Modified Davis grading. 45° FOV. 848x848px.
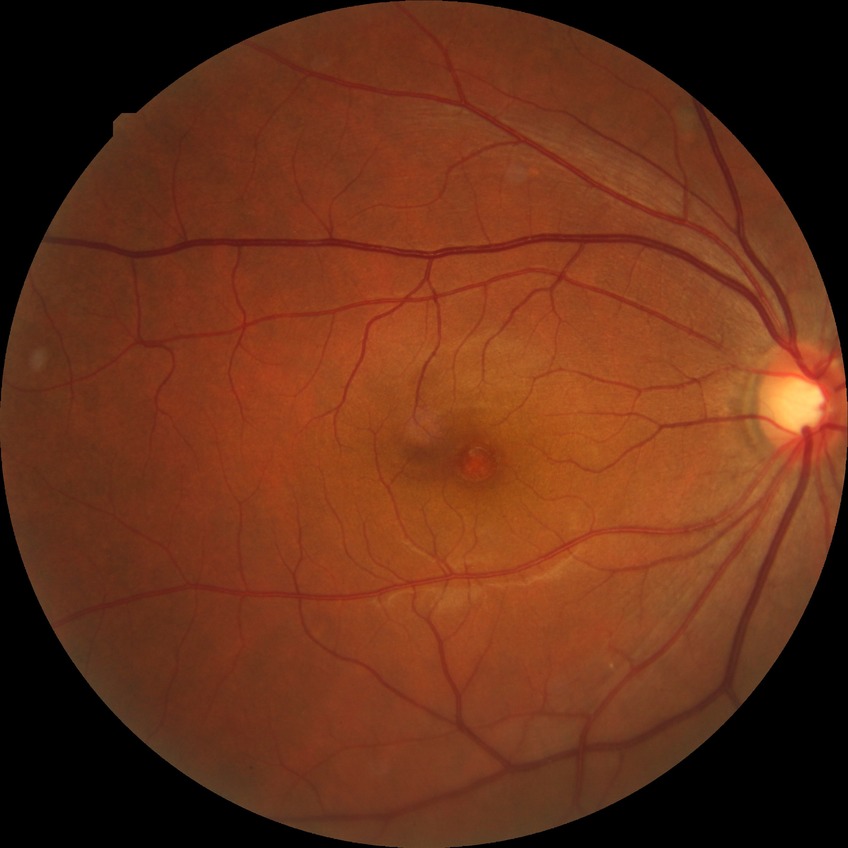
Retinopathy stage: no diabetic retinopathy.